2212 x 1659 pixels; retinal fundus photograph.
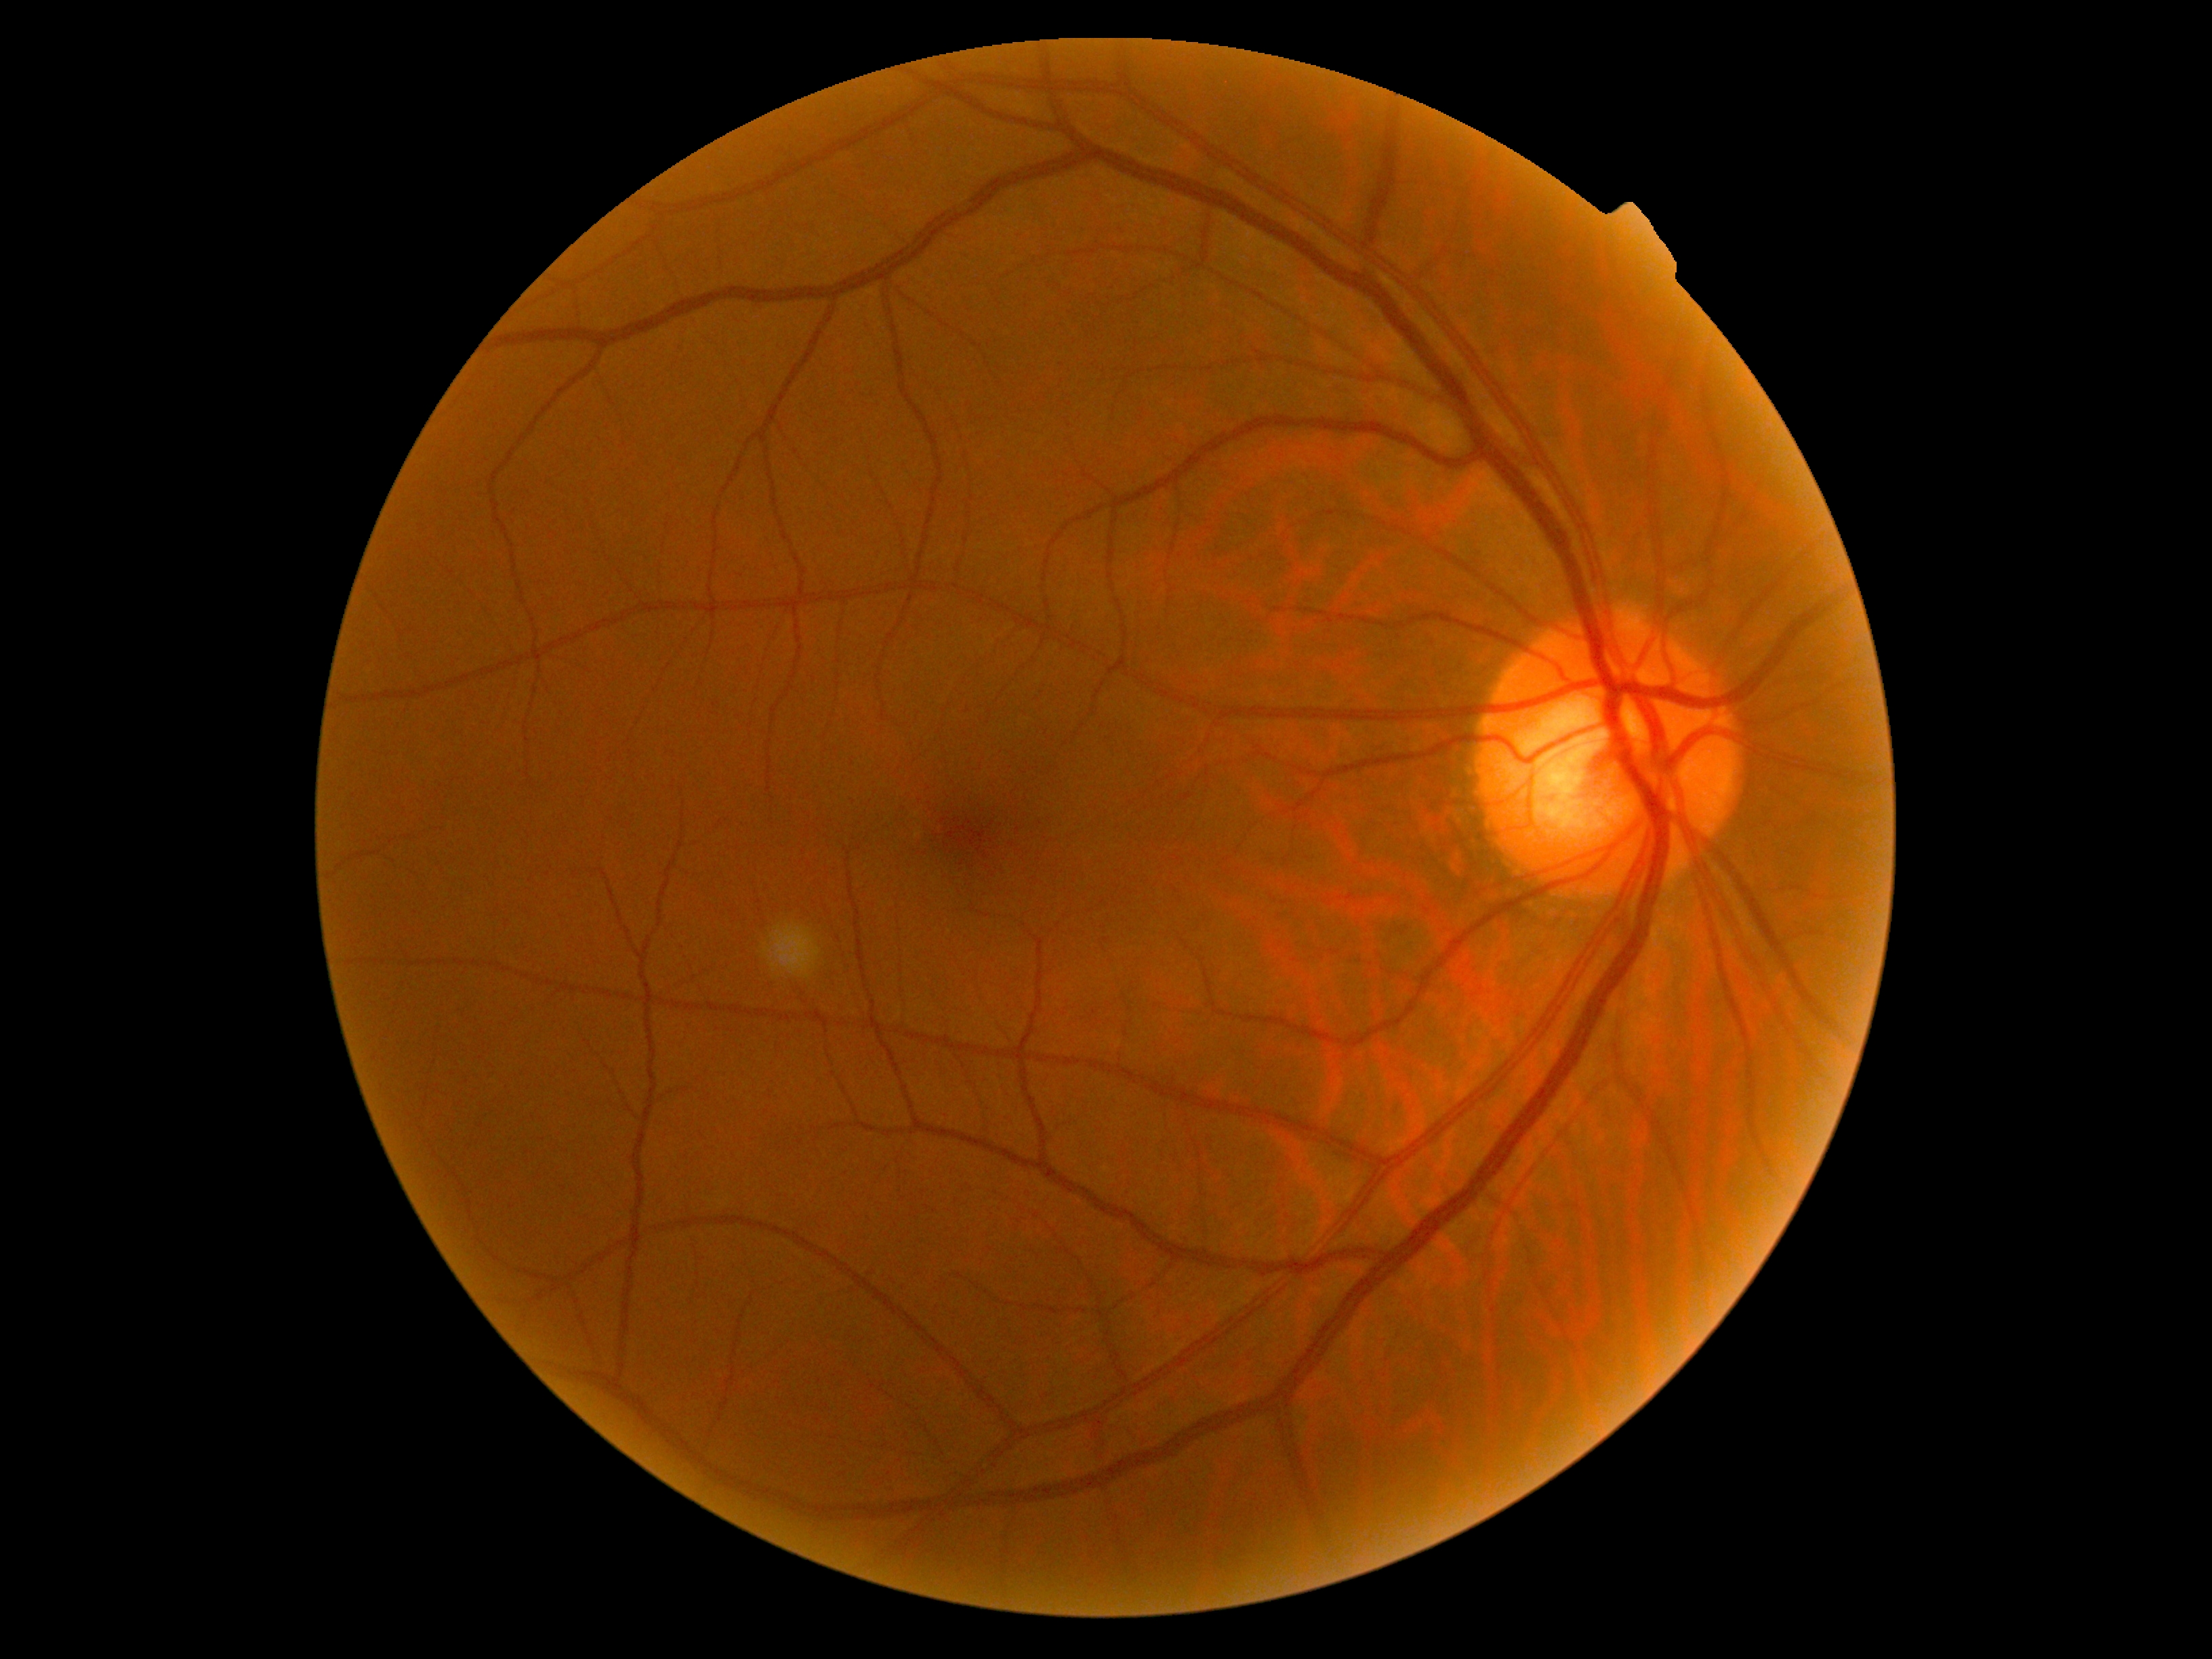 No DR findings.
Diabetic retinopathy (DR) is grade 0.